Color fundus photograph.
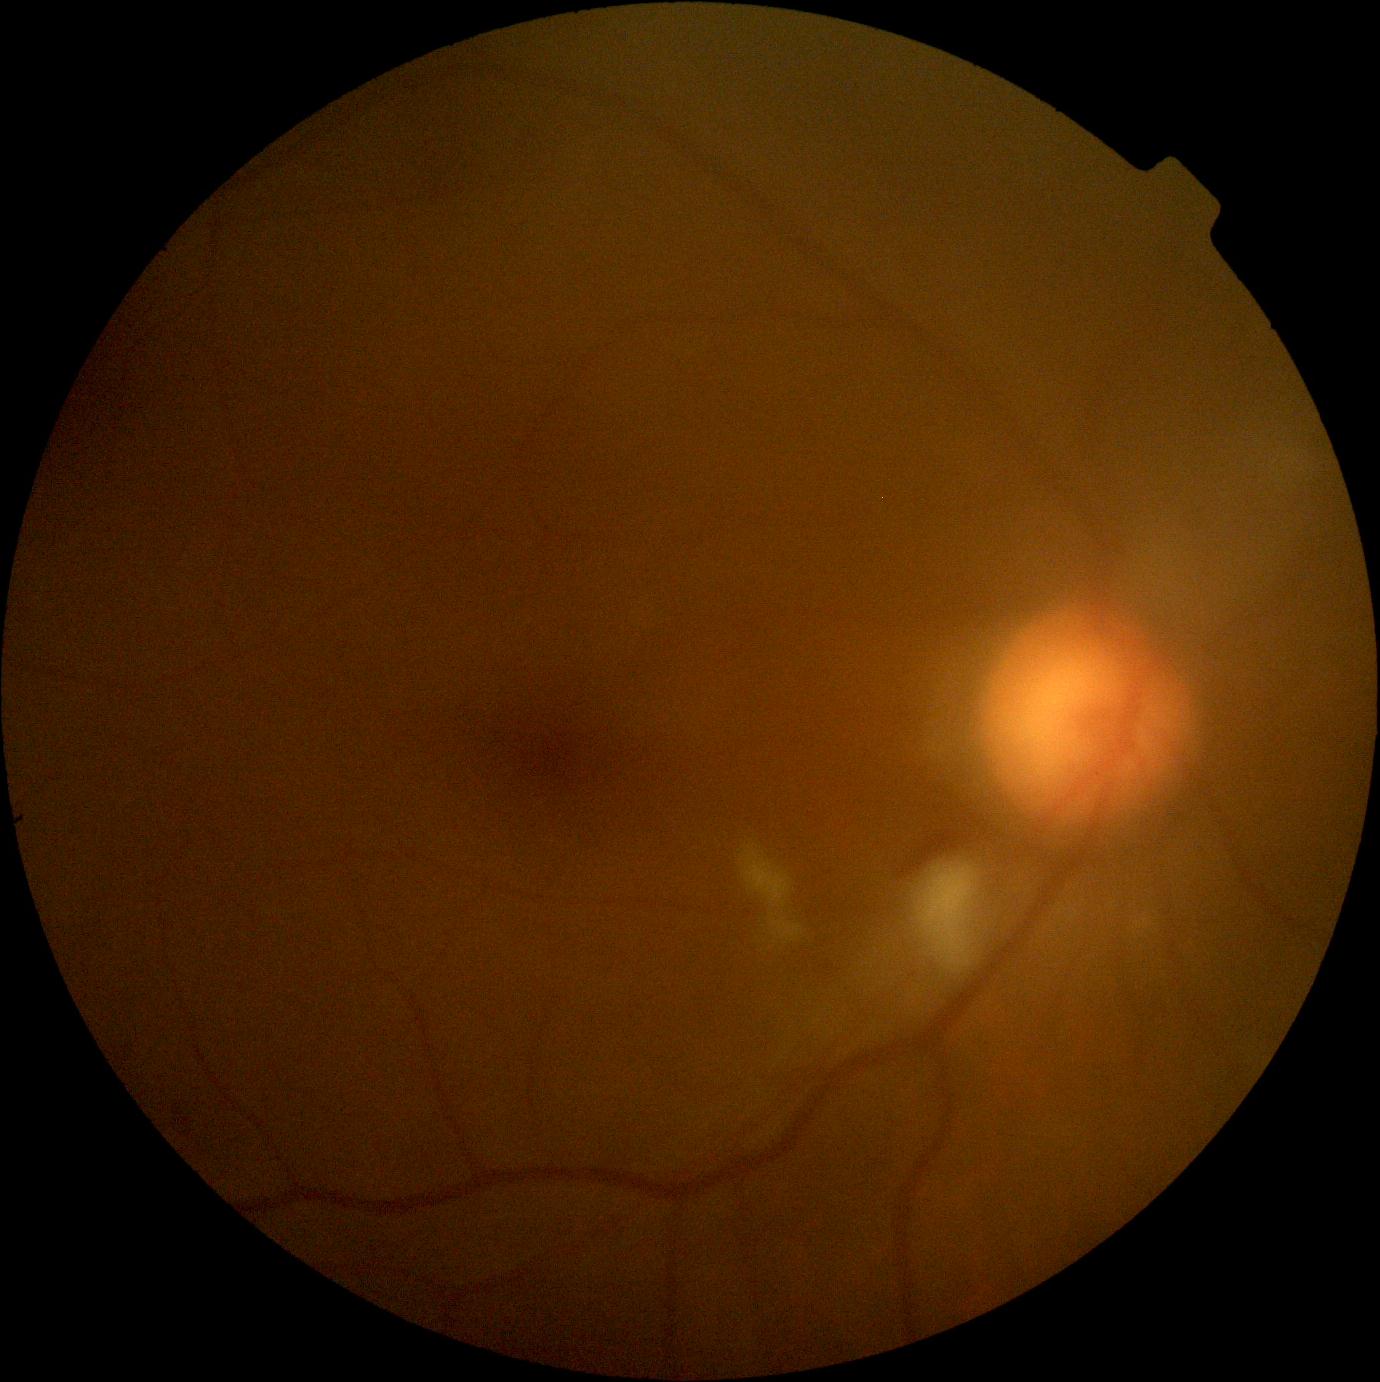
Diabetic retinopathy grade is moderate non-proliferative diabetic retinopathy (2).